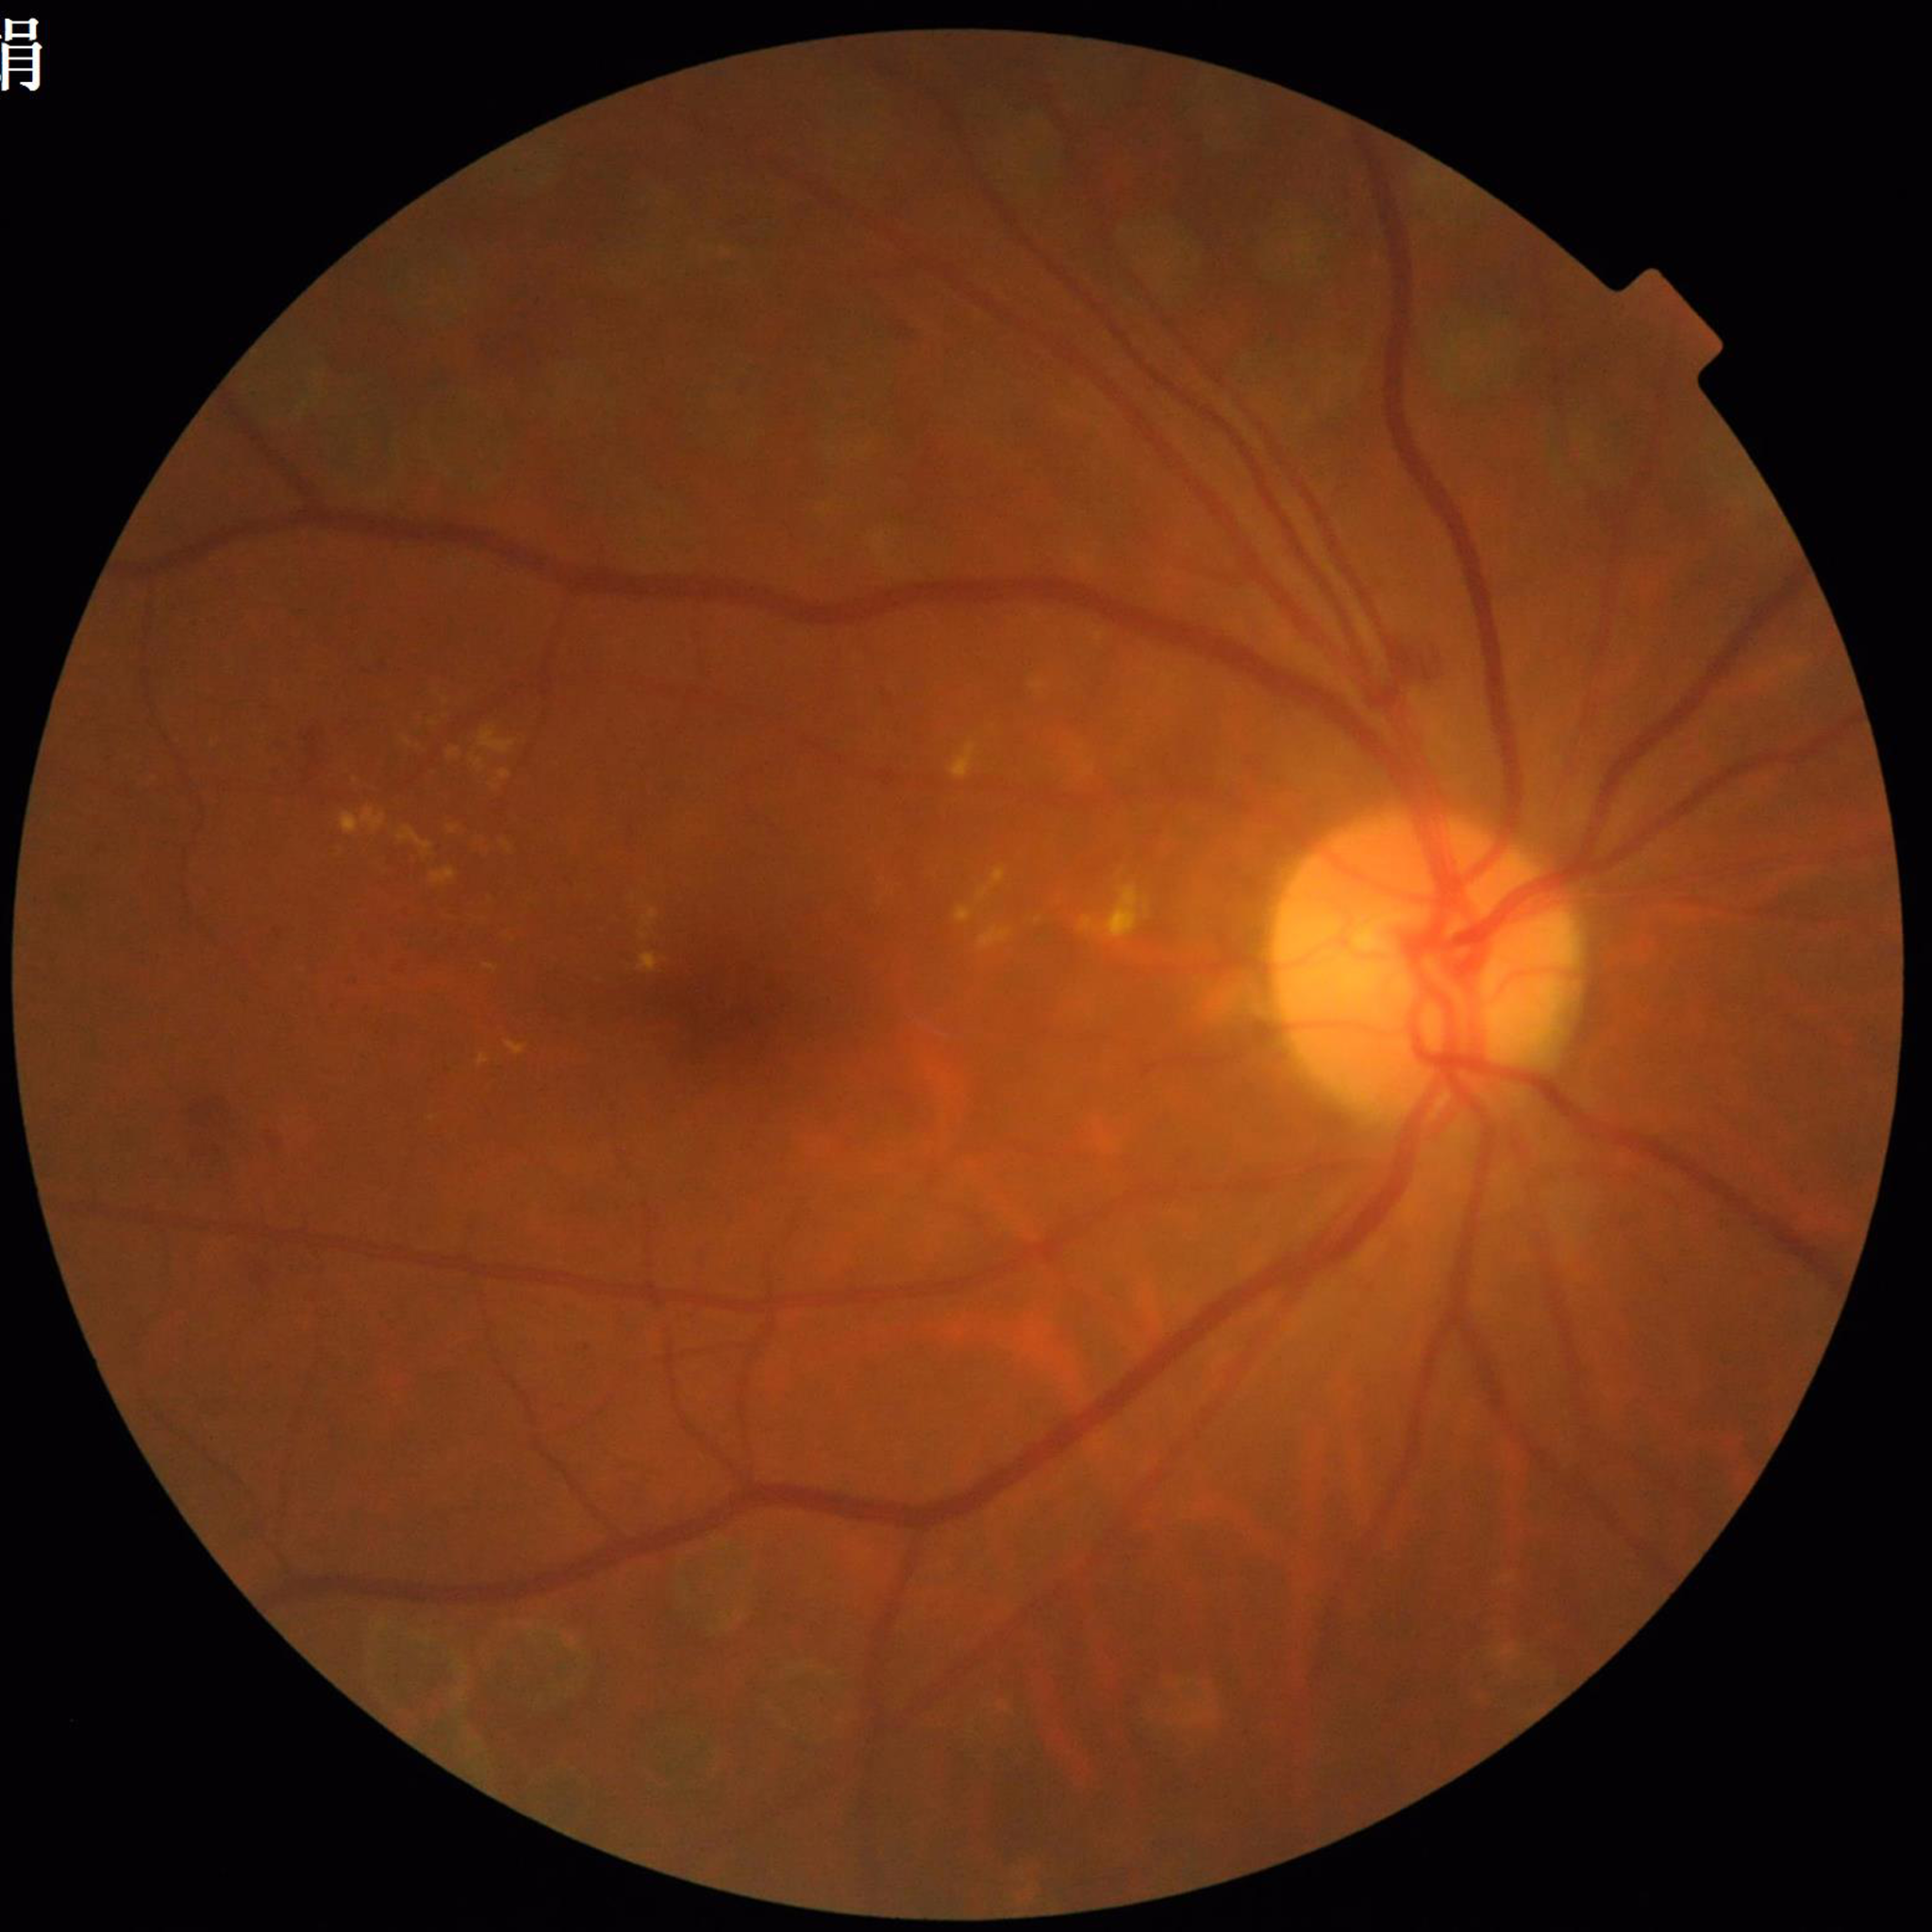
Disease class: diabetic retinopathy.